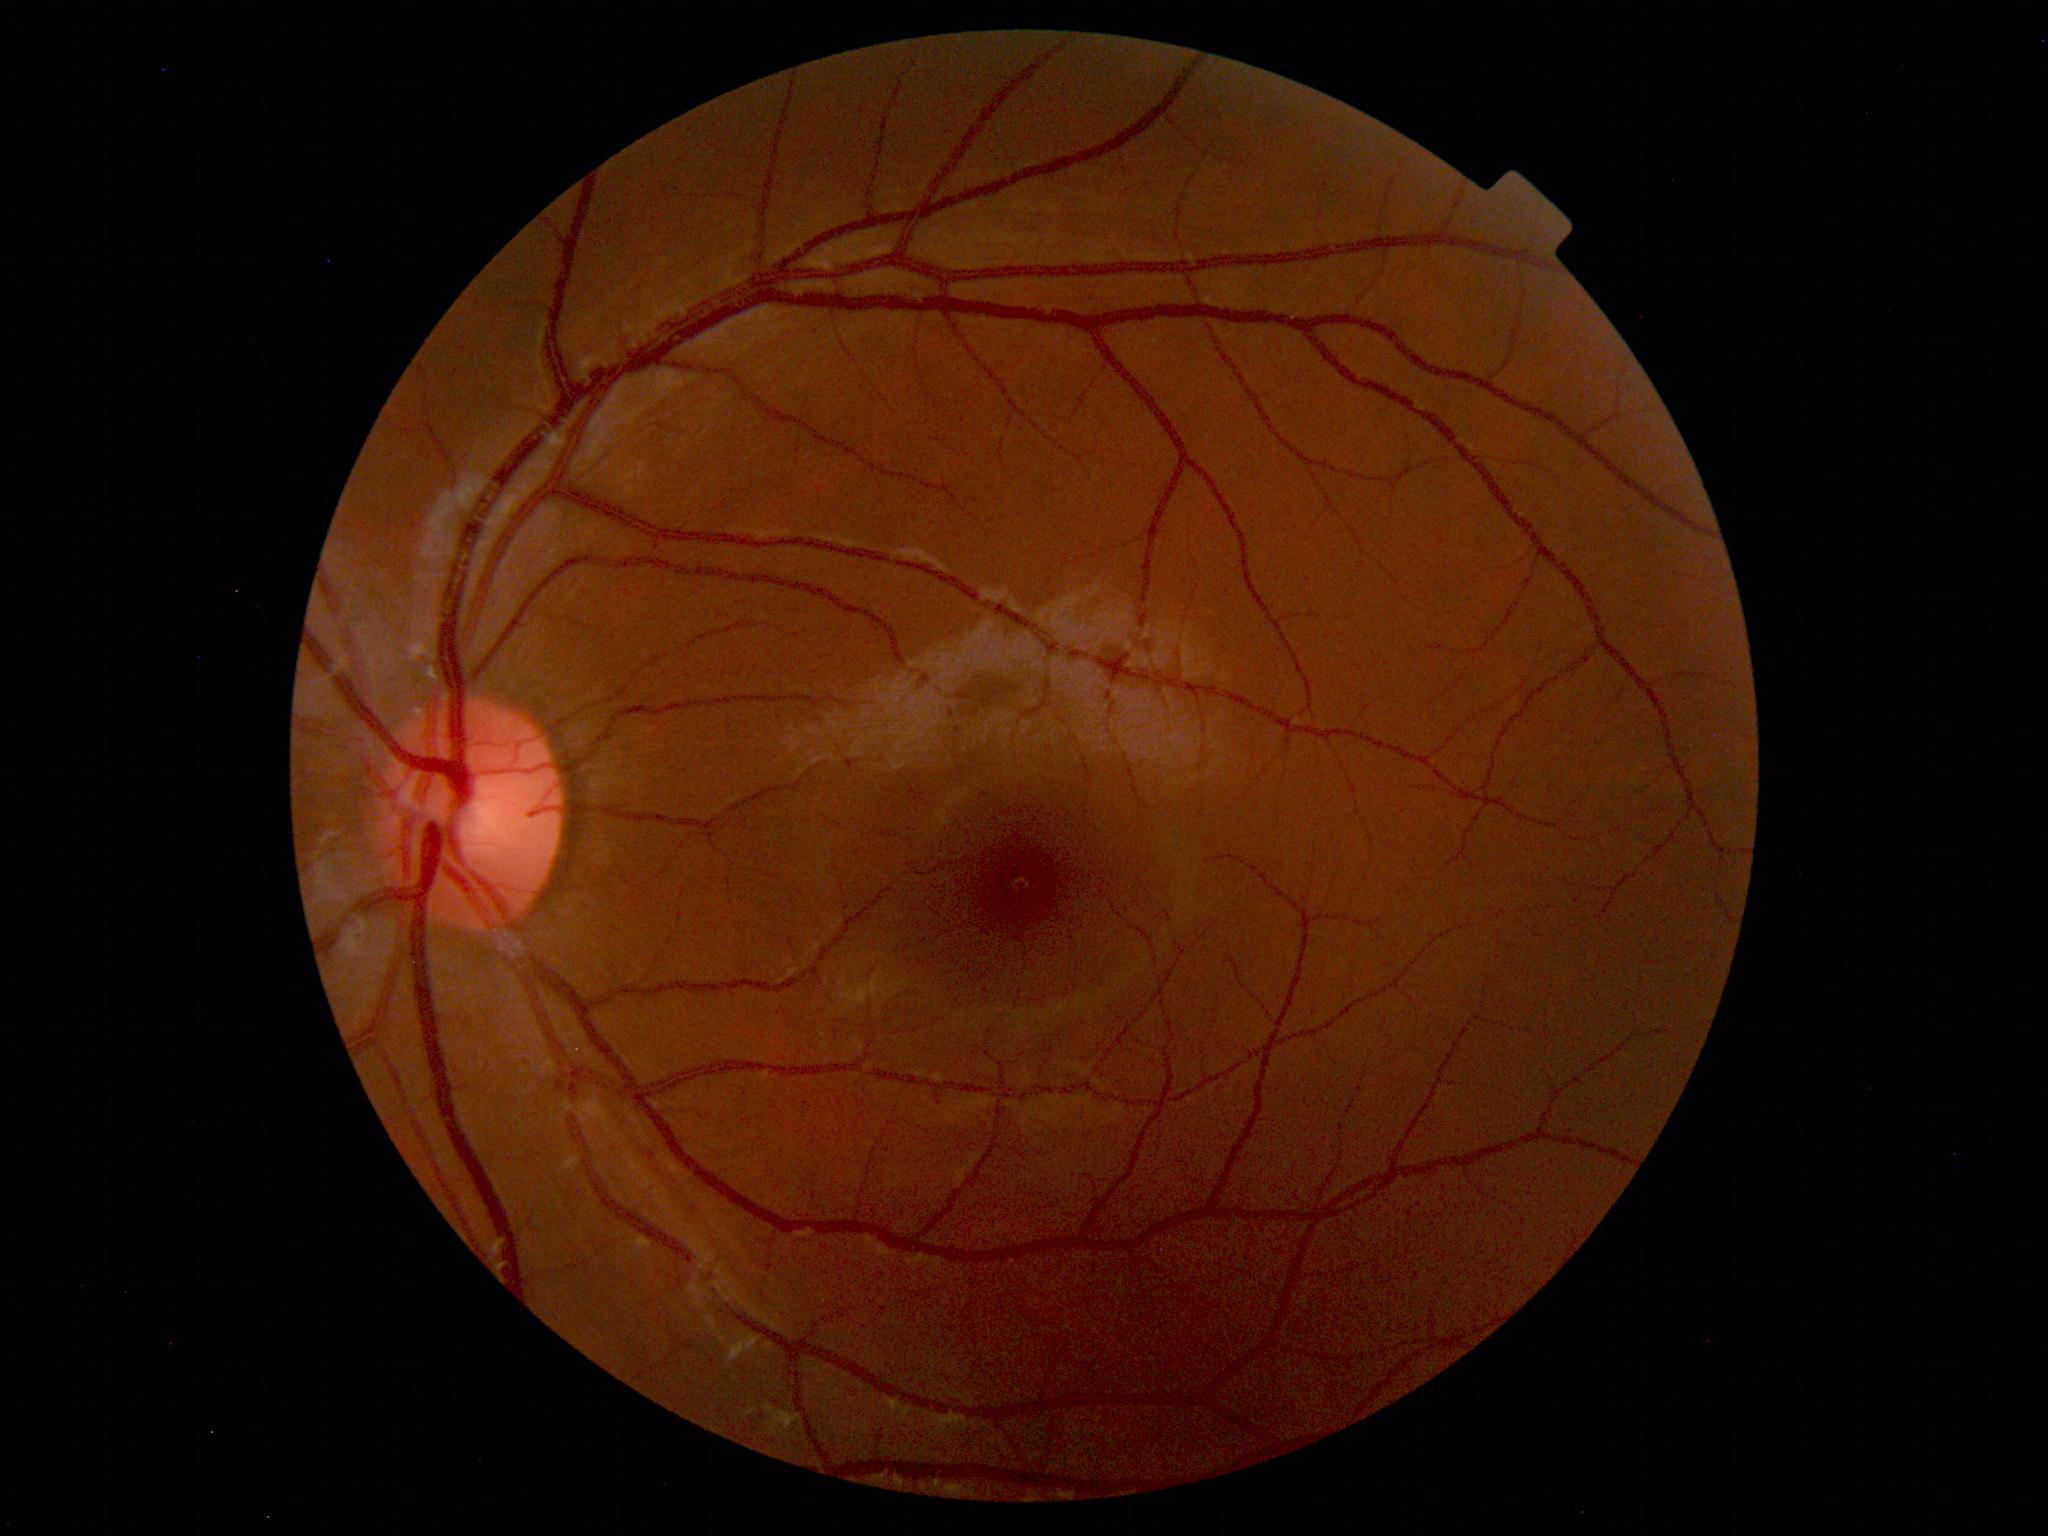 Normal retinal fundus image with no abnormalities identified.